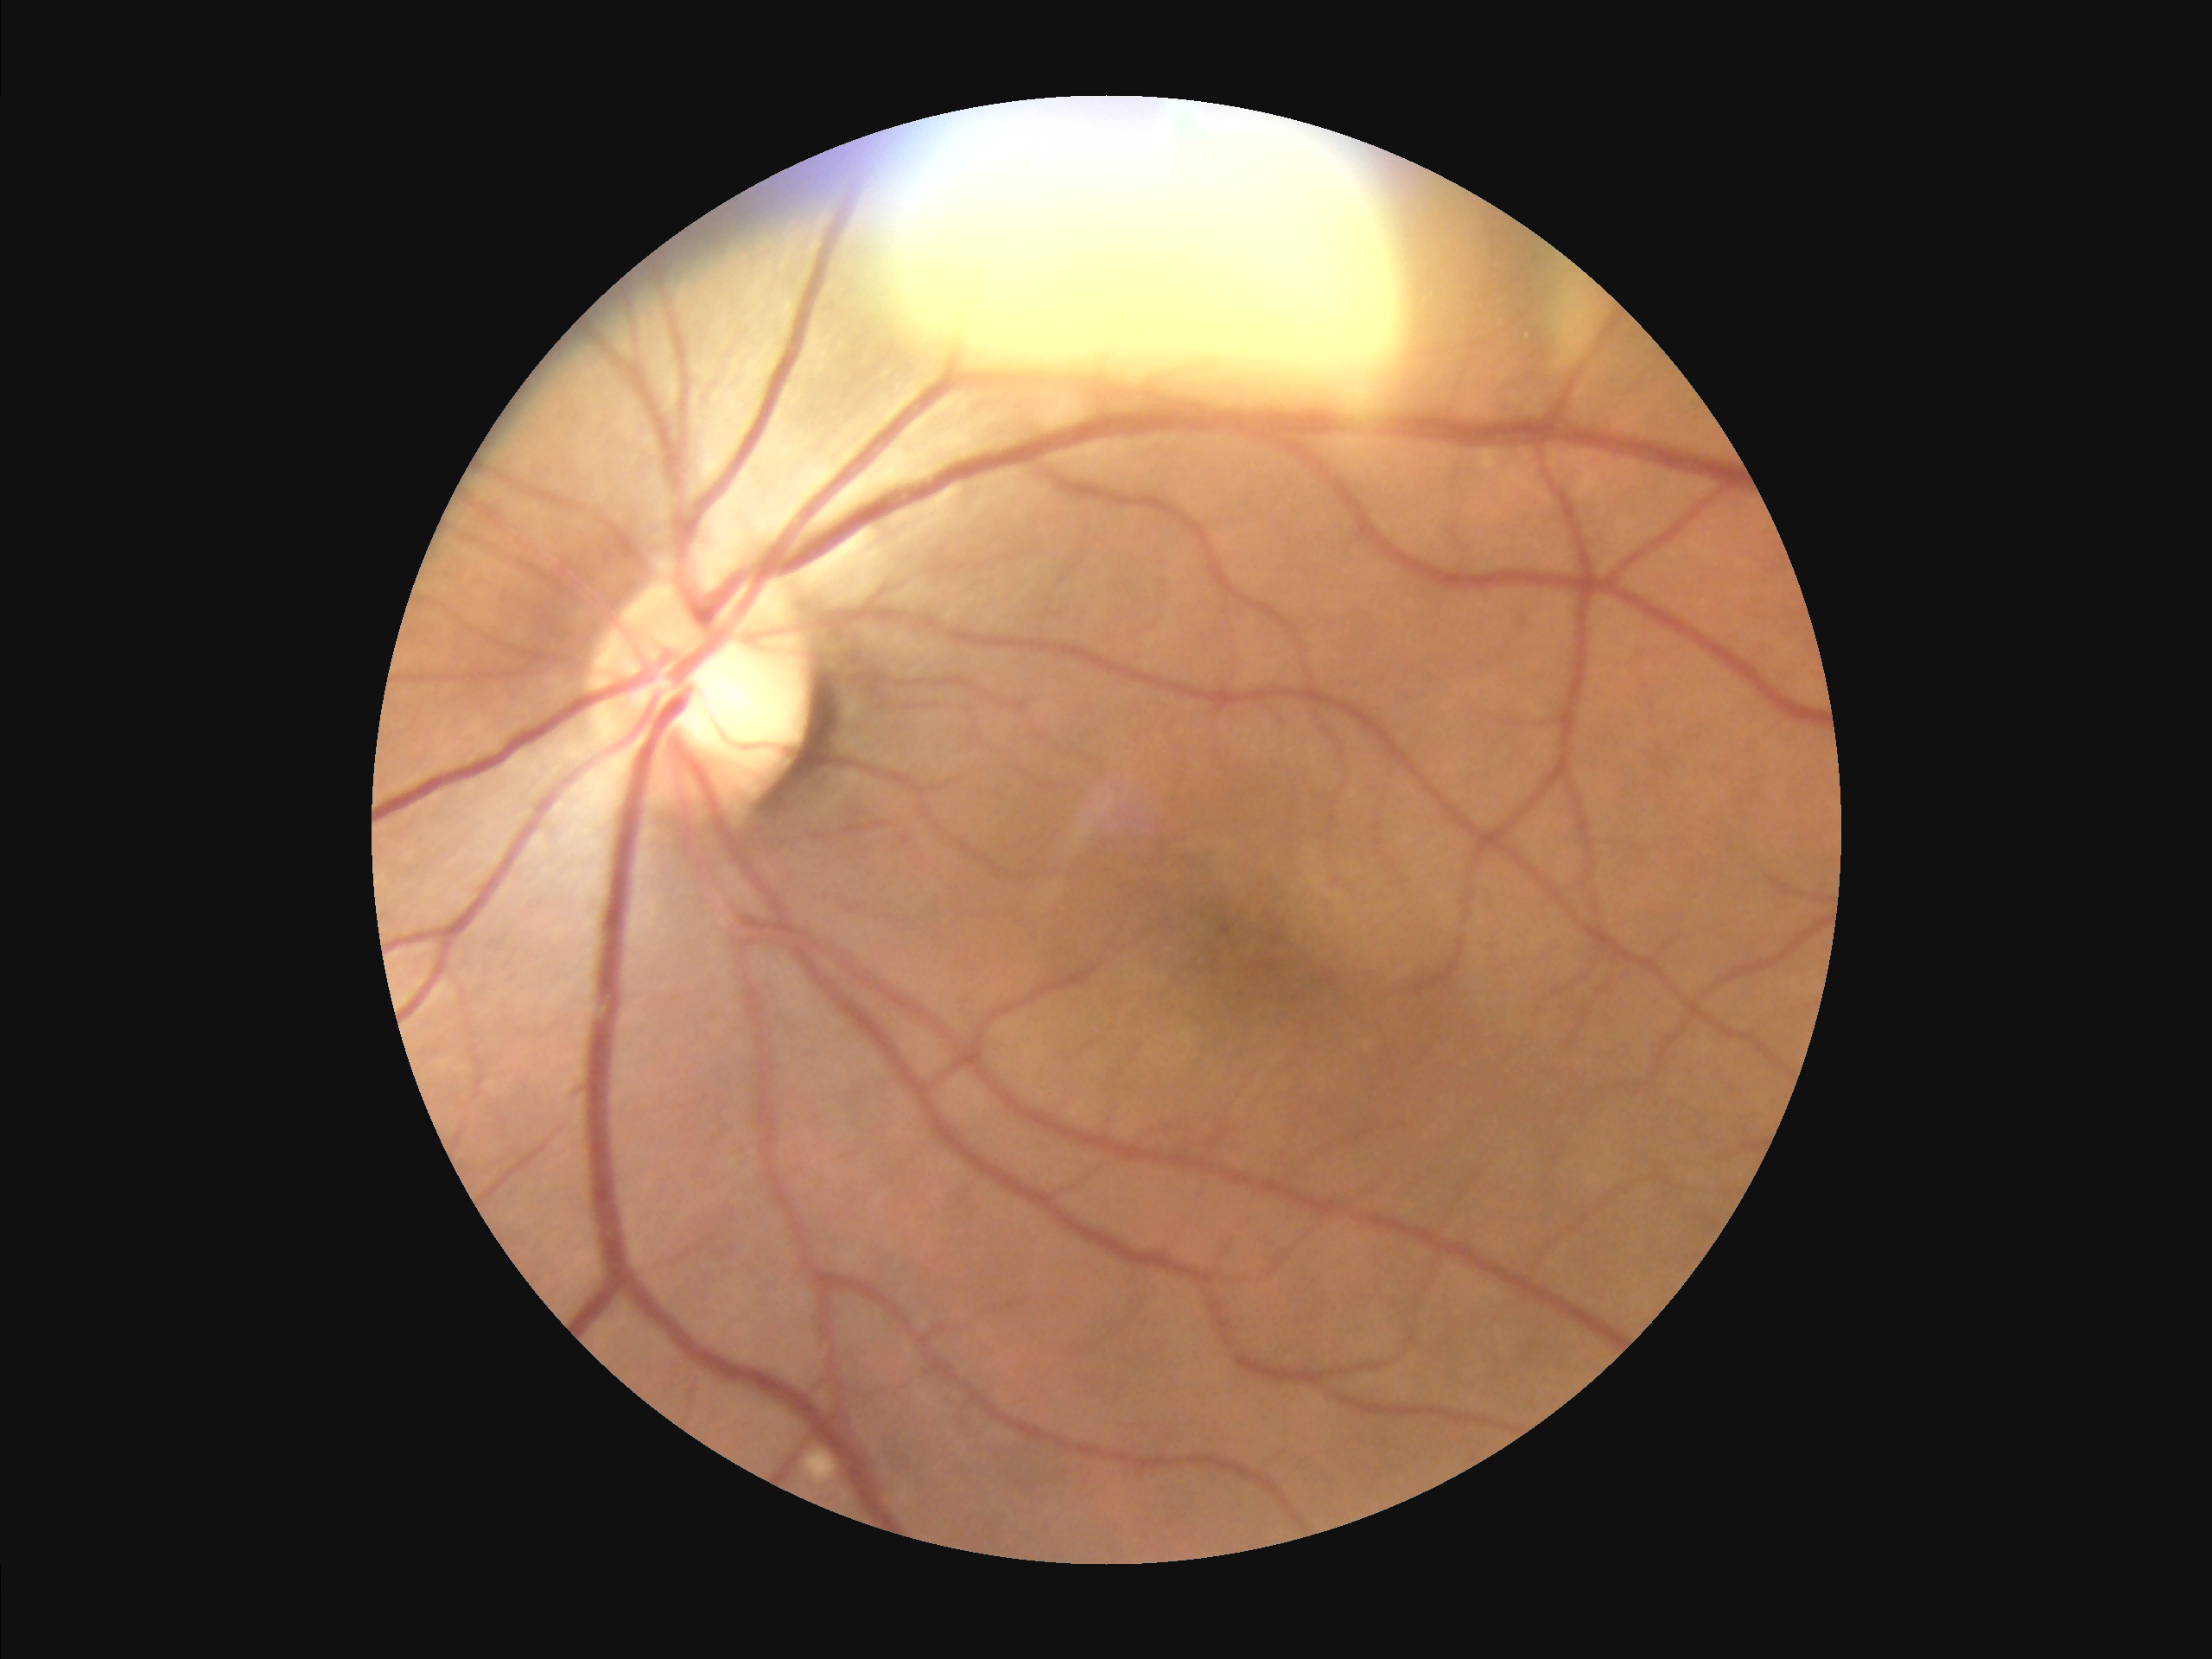 Illumination and color are suboptimal. Image quality is adequate for diagnostic use. The image is clear.